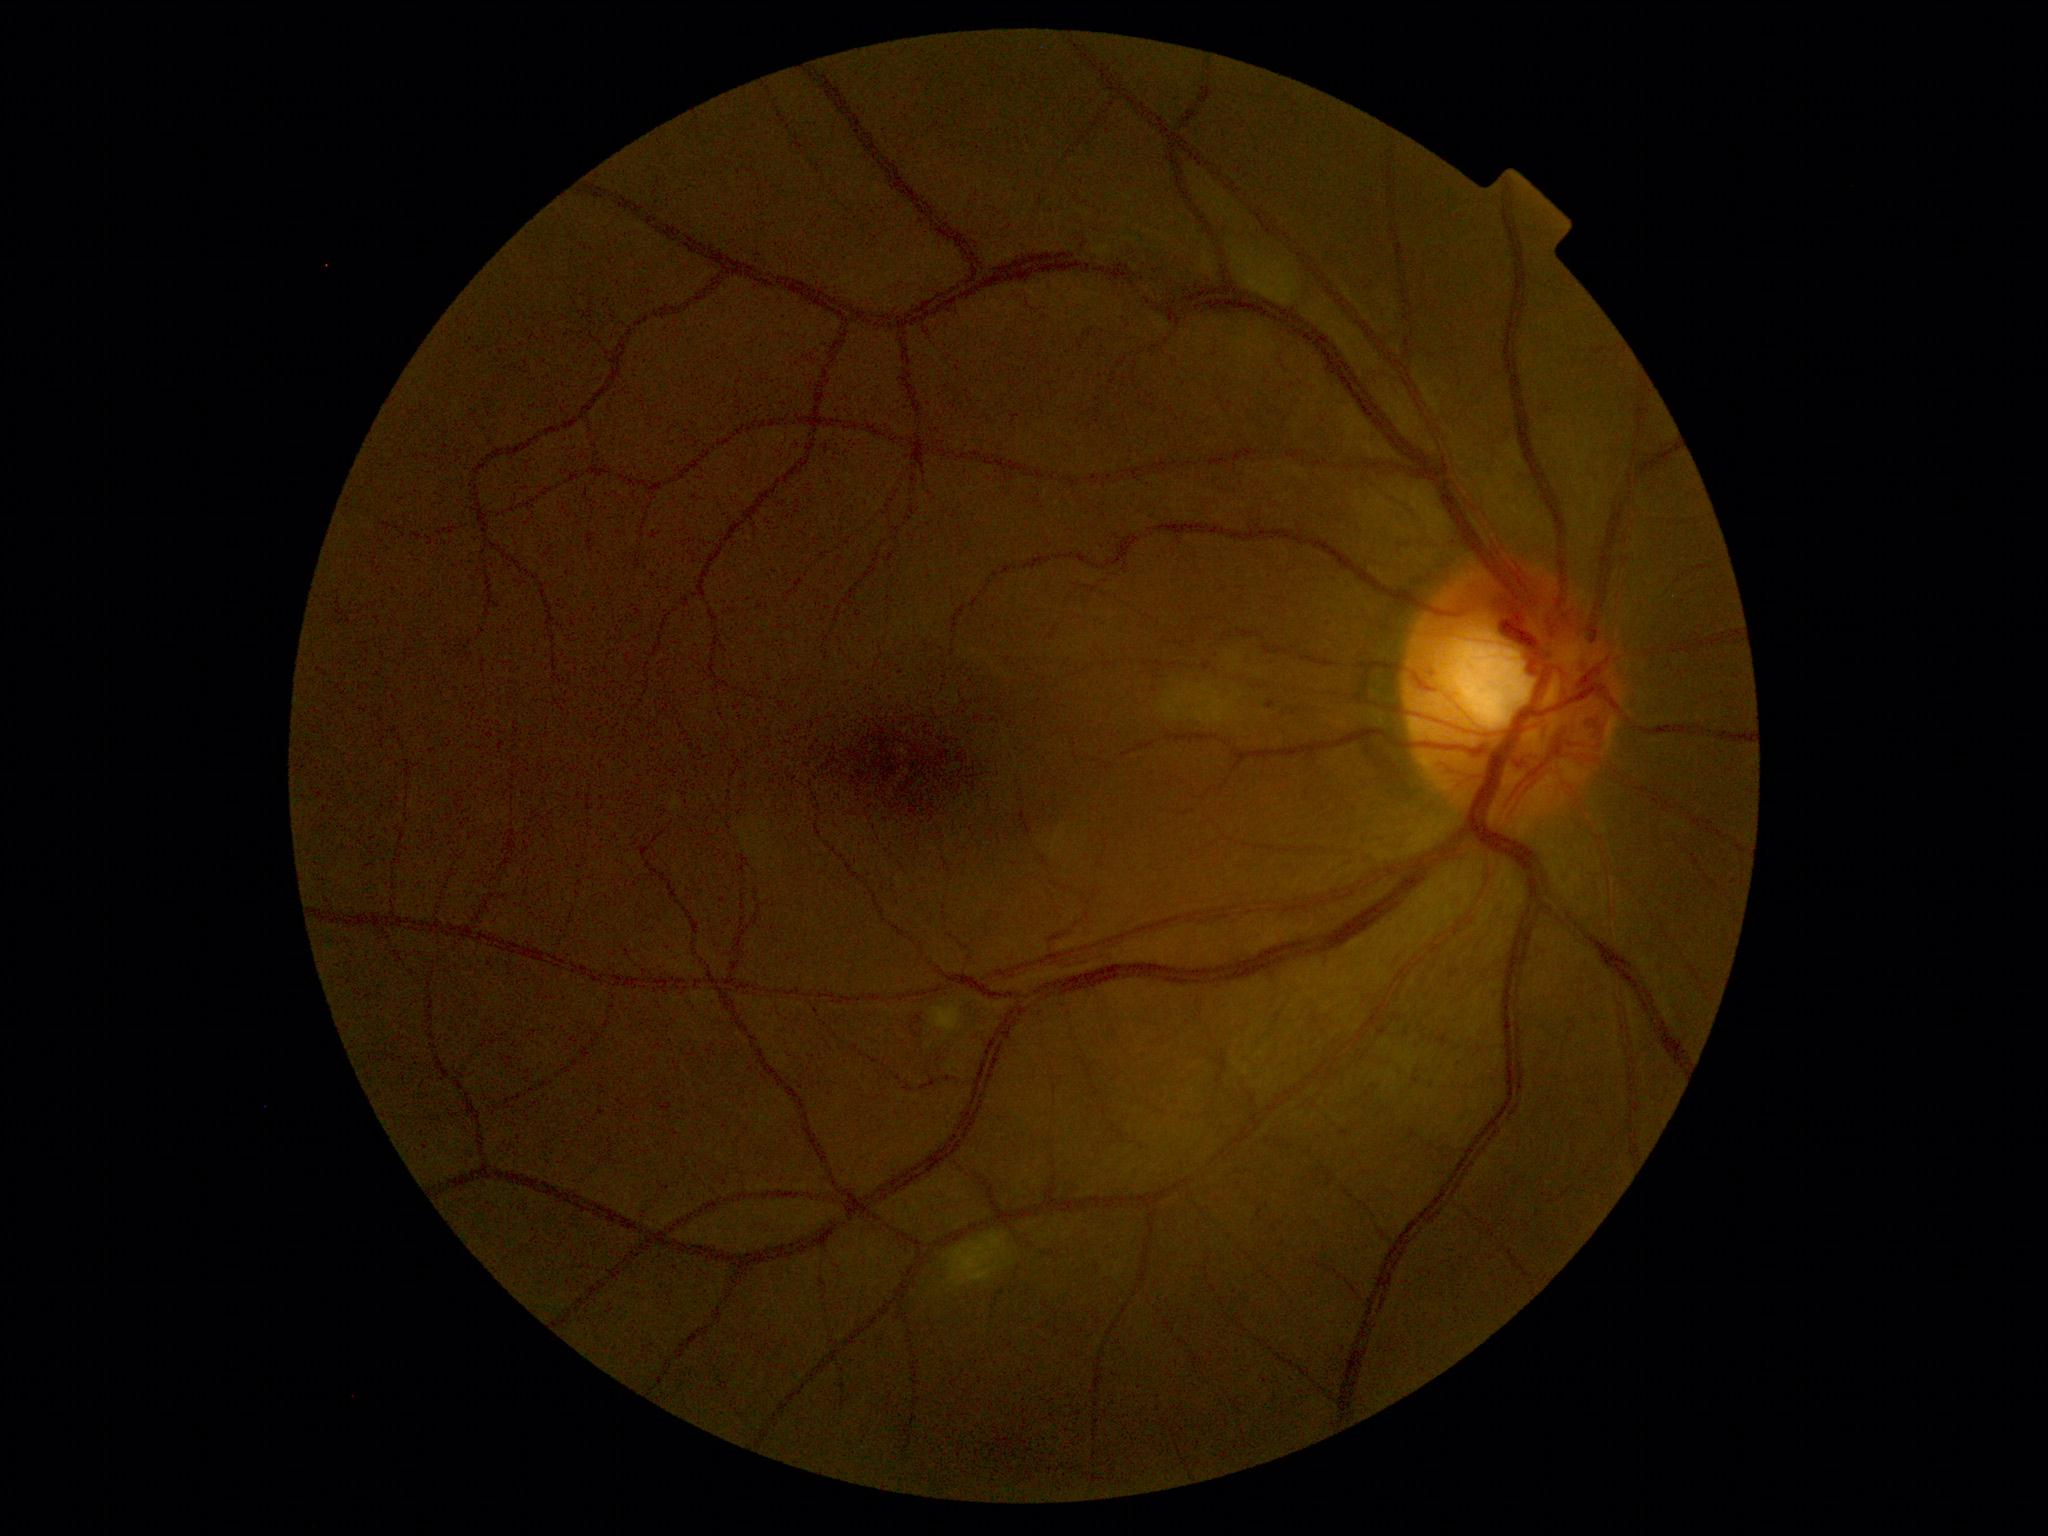

DR stage: 2/4.